Image size 2048x1536 — 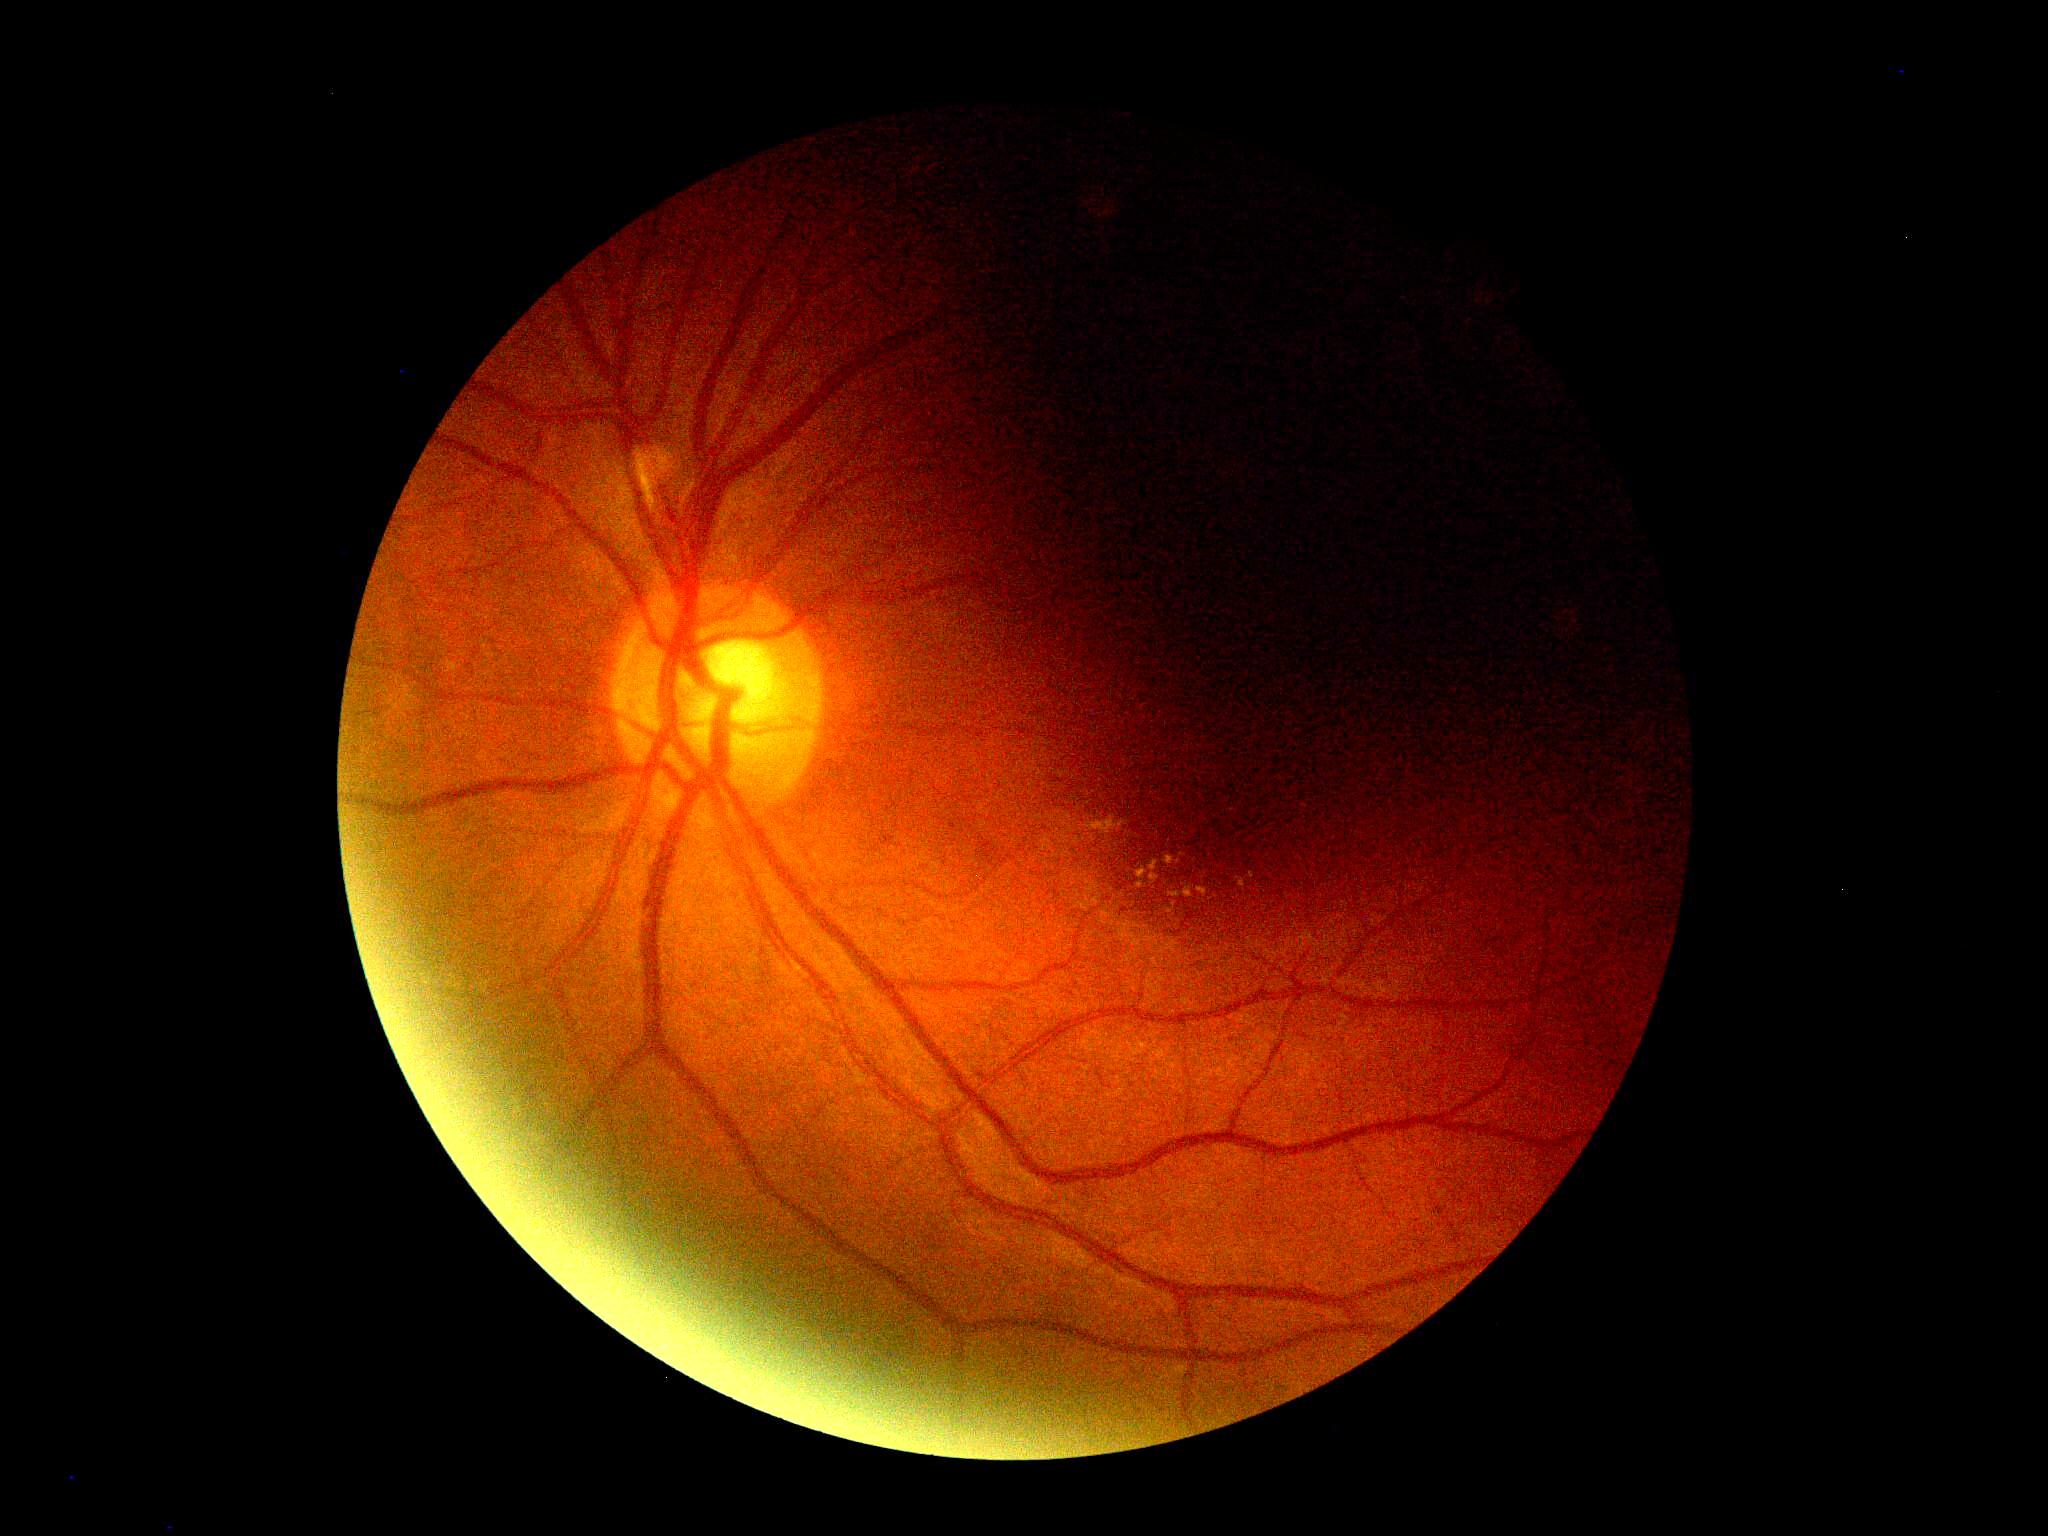 - diabetic retinopathy severity — 2
- DR class — non-proliferative diabetic retinopathy